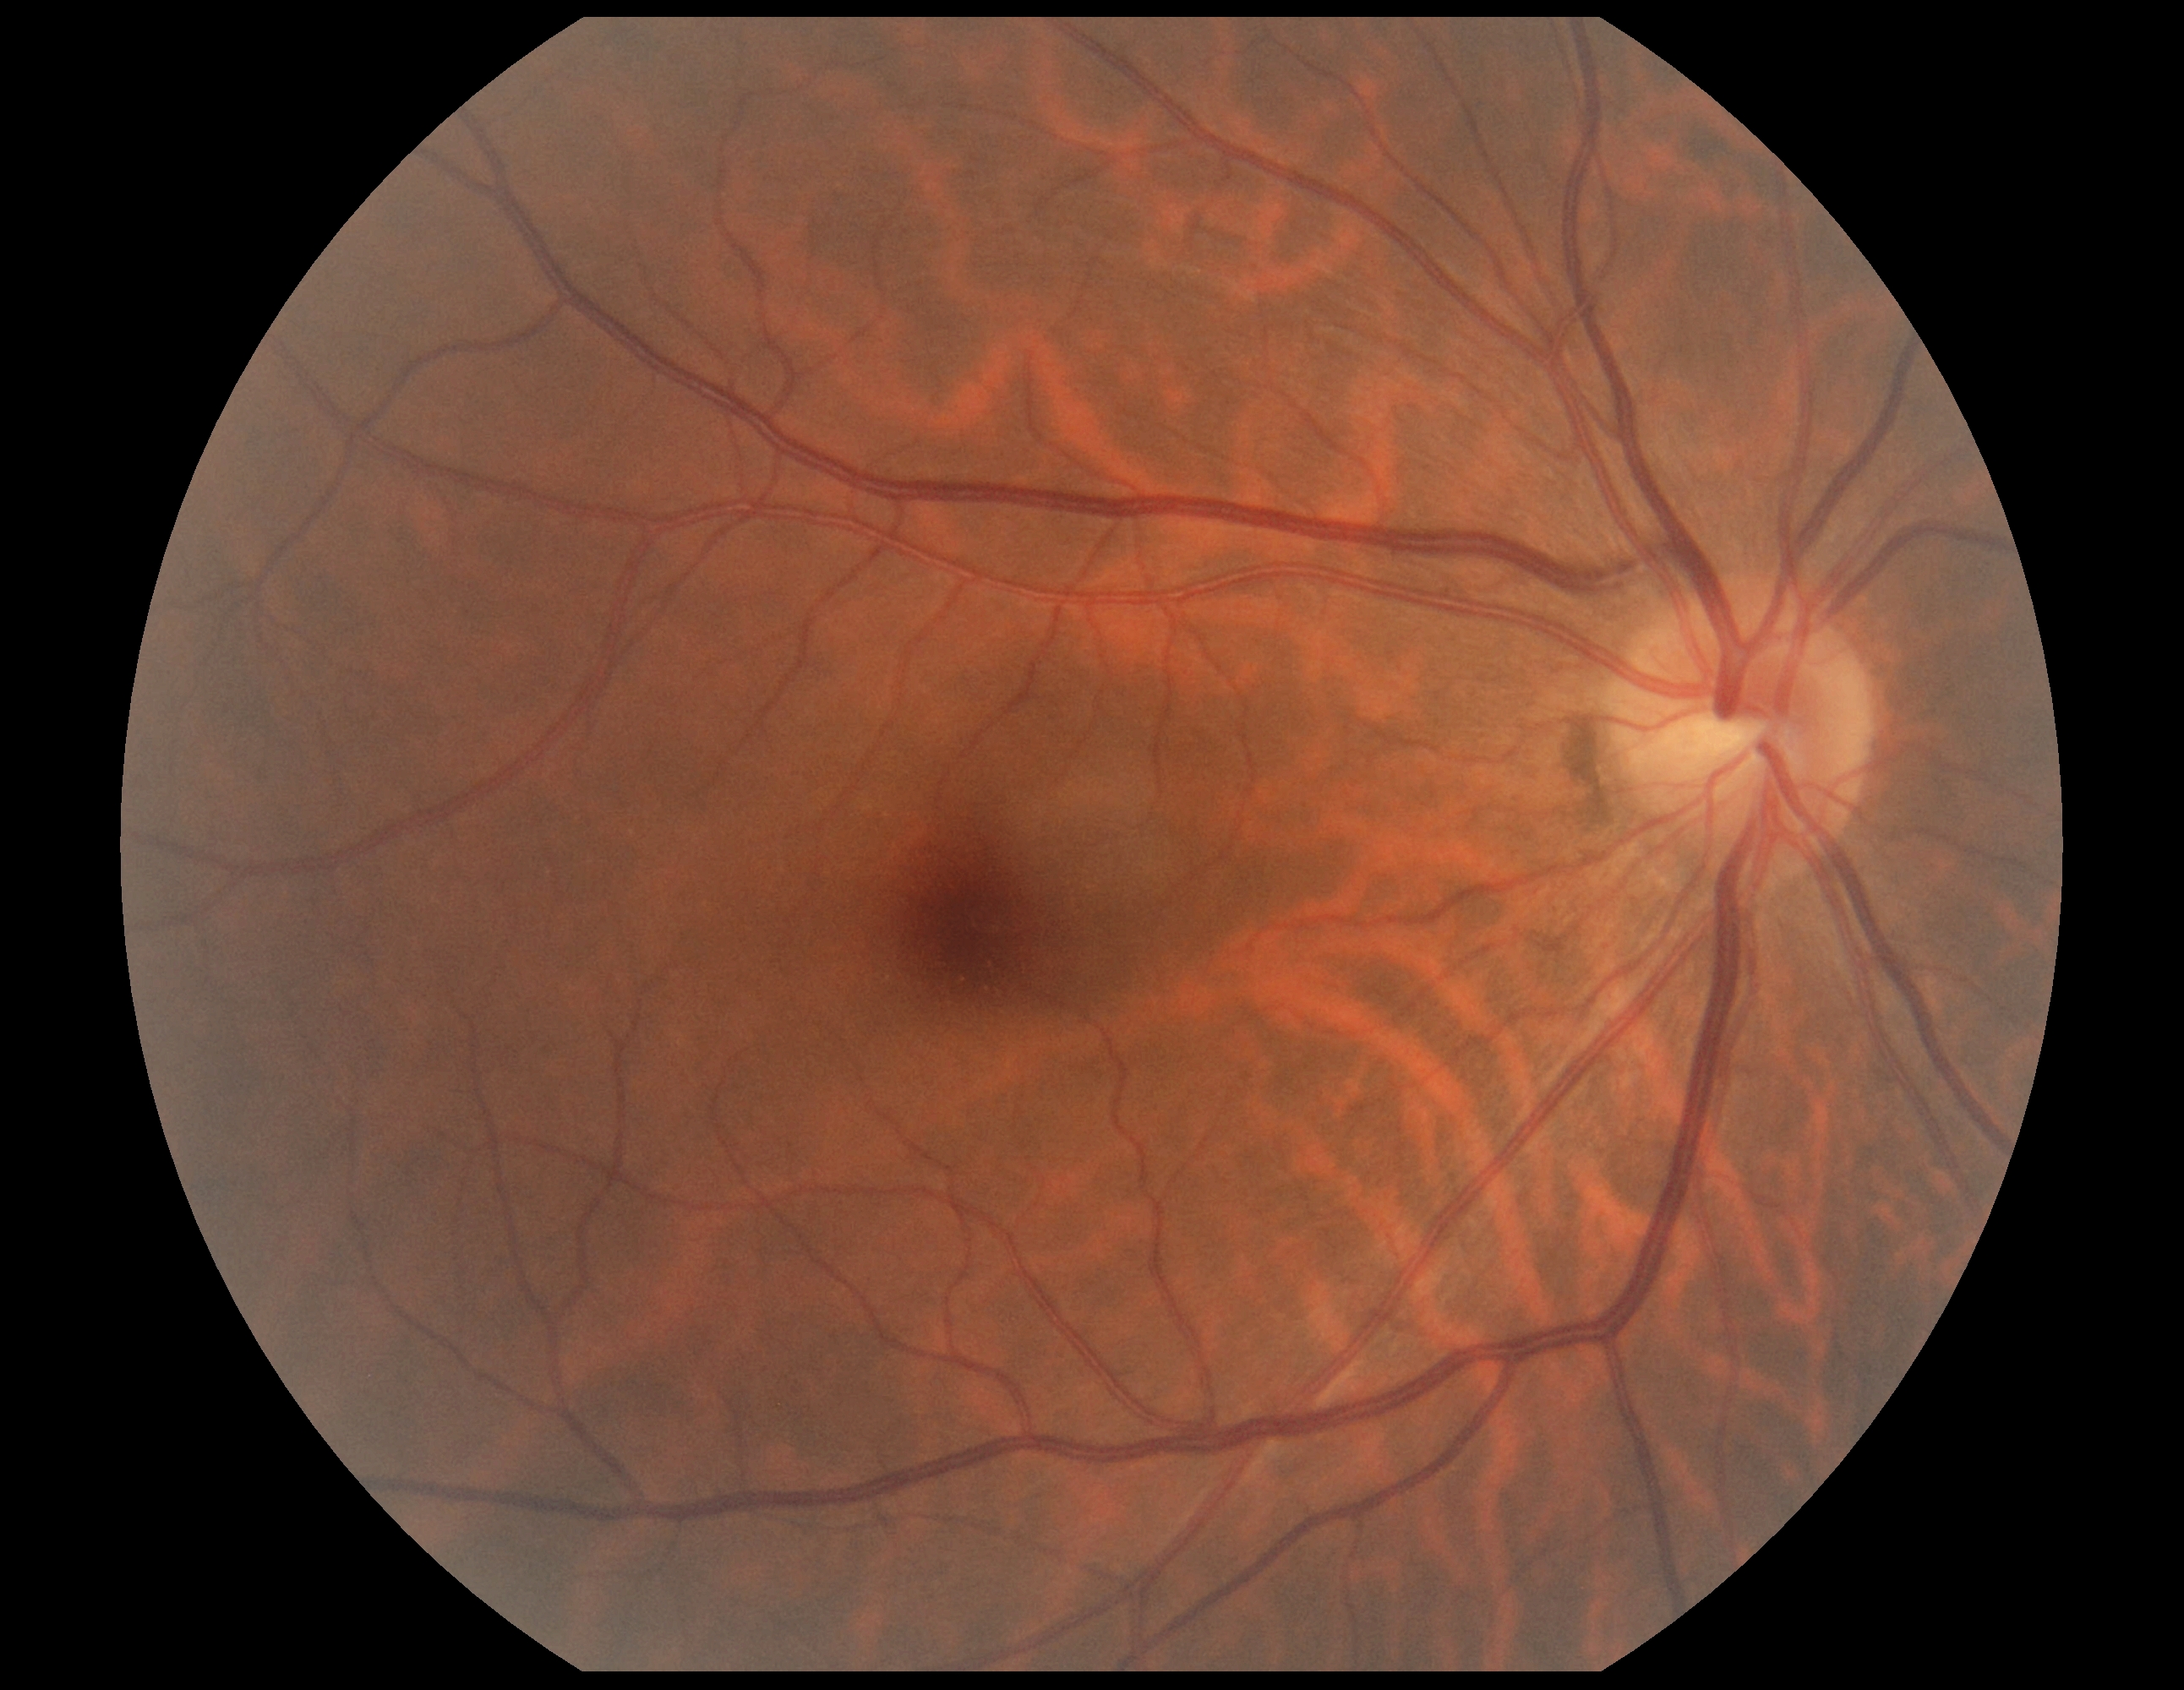
DR stage: no apparent diabetic retinopathy (grade 0) — no visible signs of diabetic retinopathy.